Diabetic retinopathy graded by the modified Davis classification, color fundus image, 45° field of view — 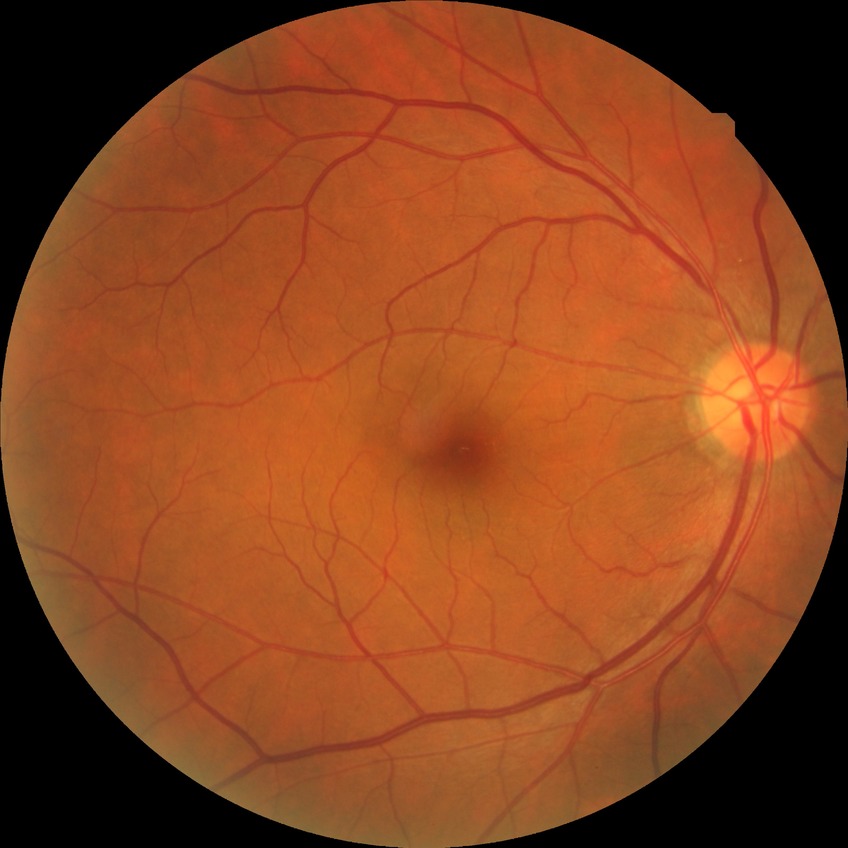

Assessment:
- Davis grade: NDR